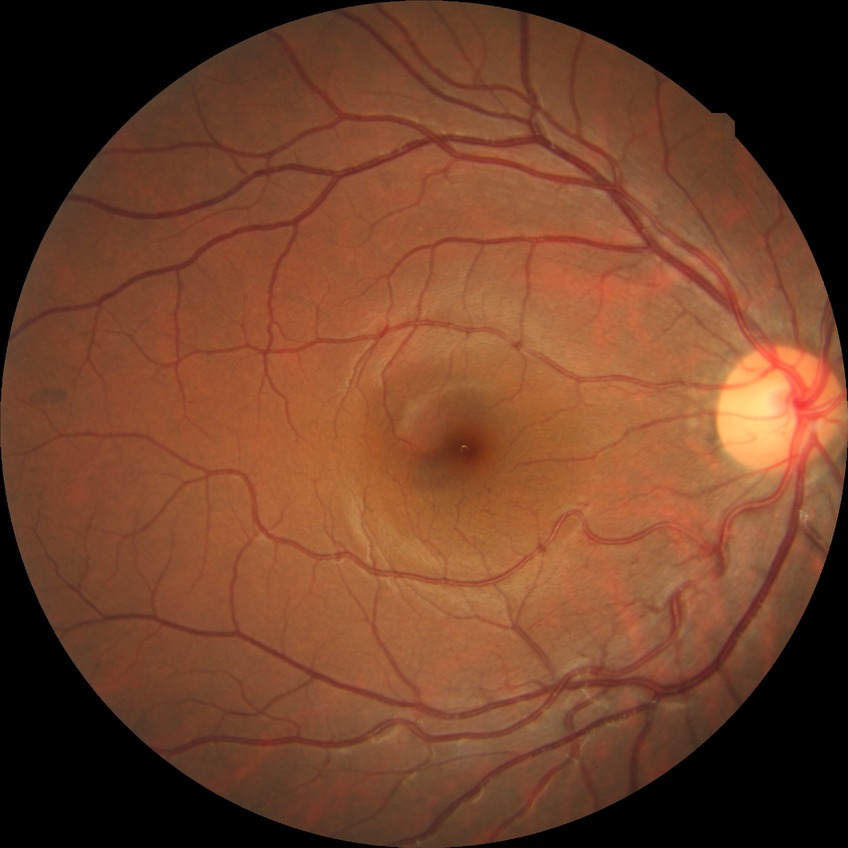

{"davis_grade": "no diabetic retinopathy"}